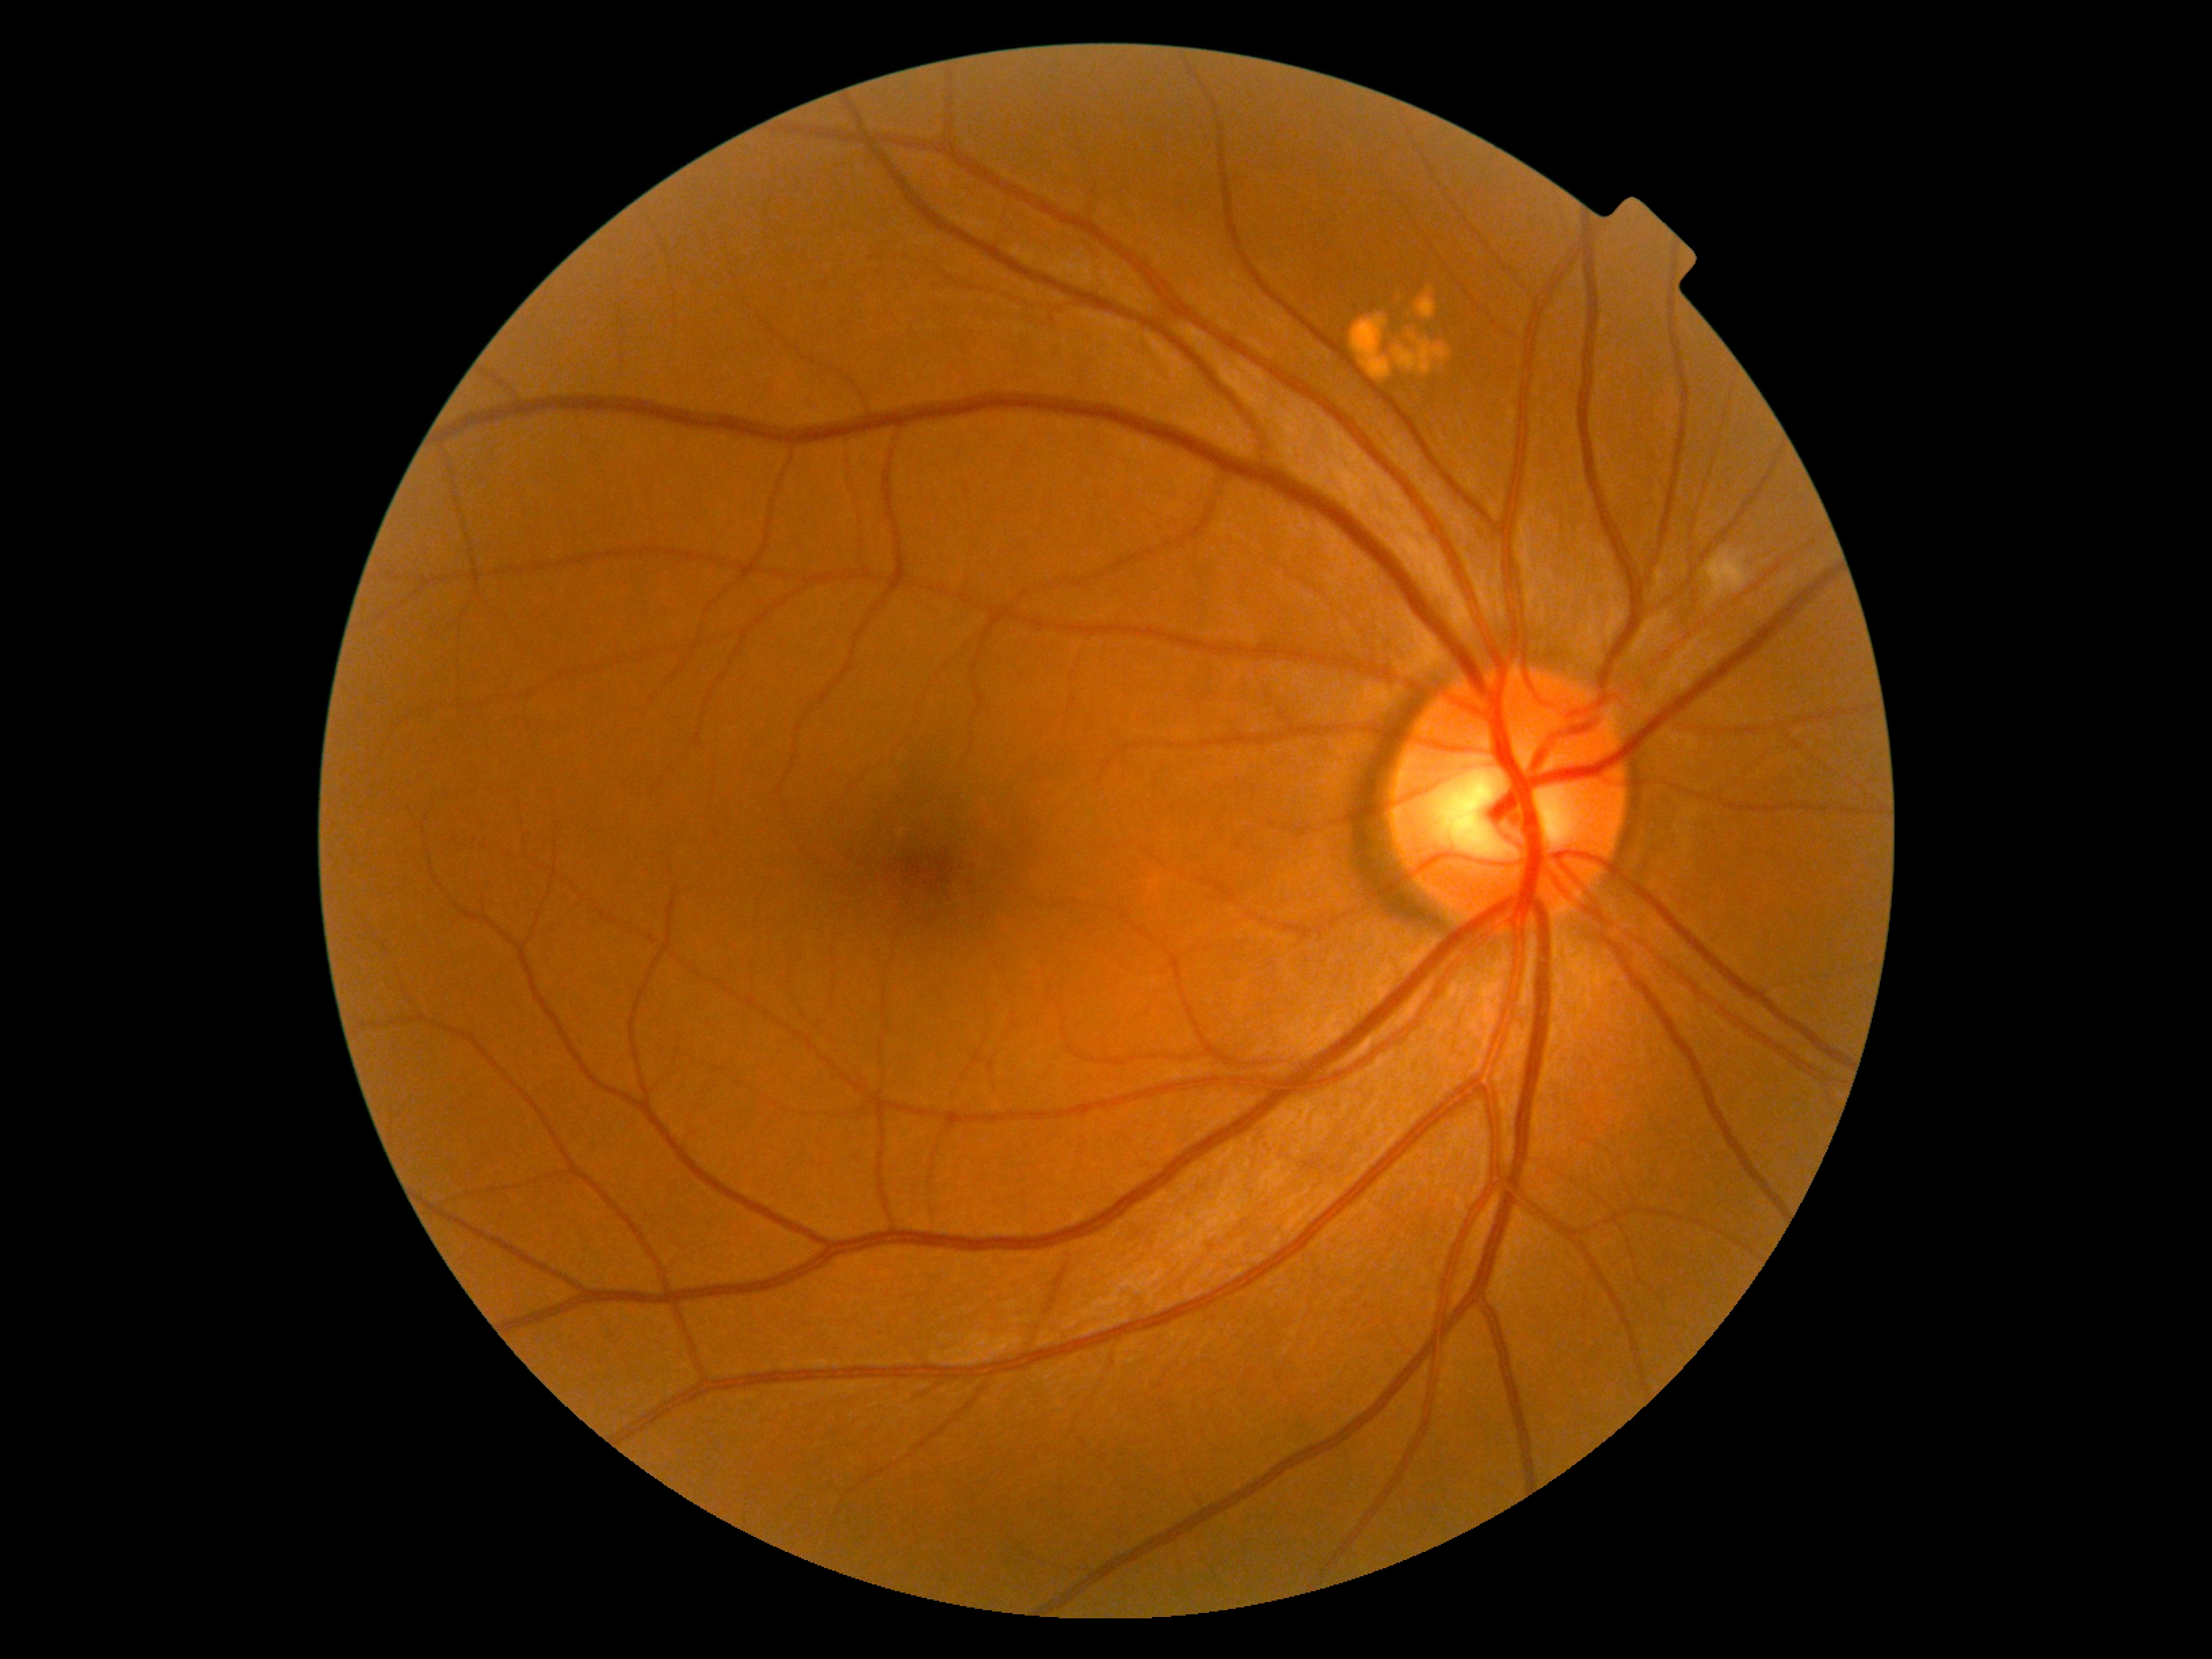

DR severity: moderate non-proliferative diabetic retinopathy (grade 2).